45-degree field of view:
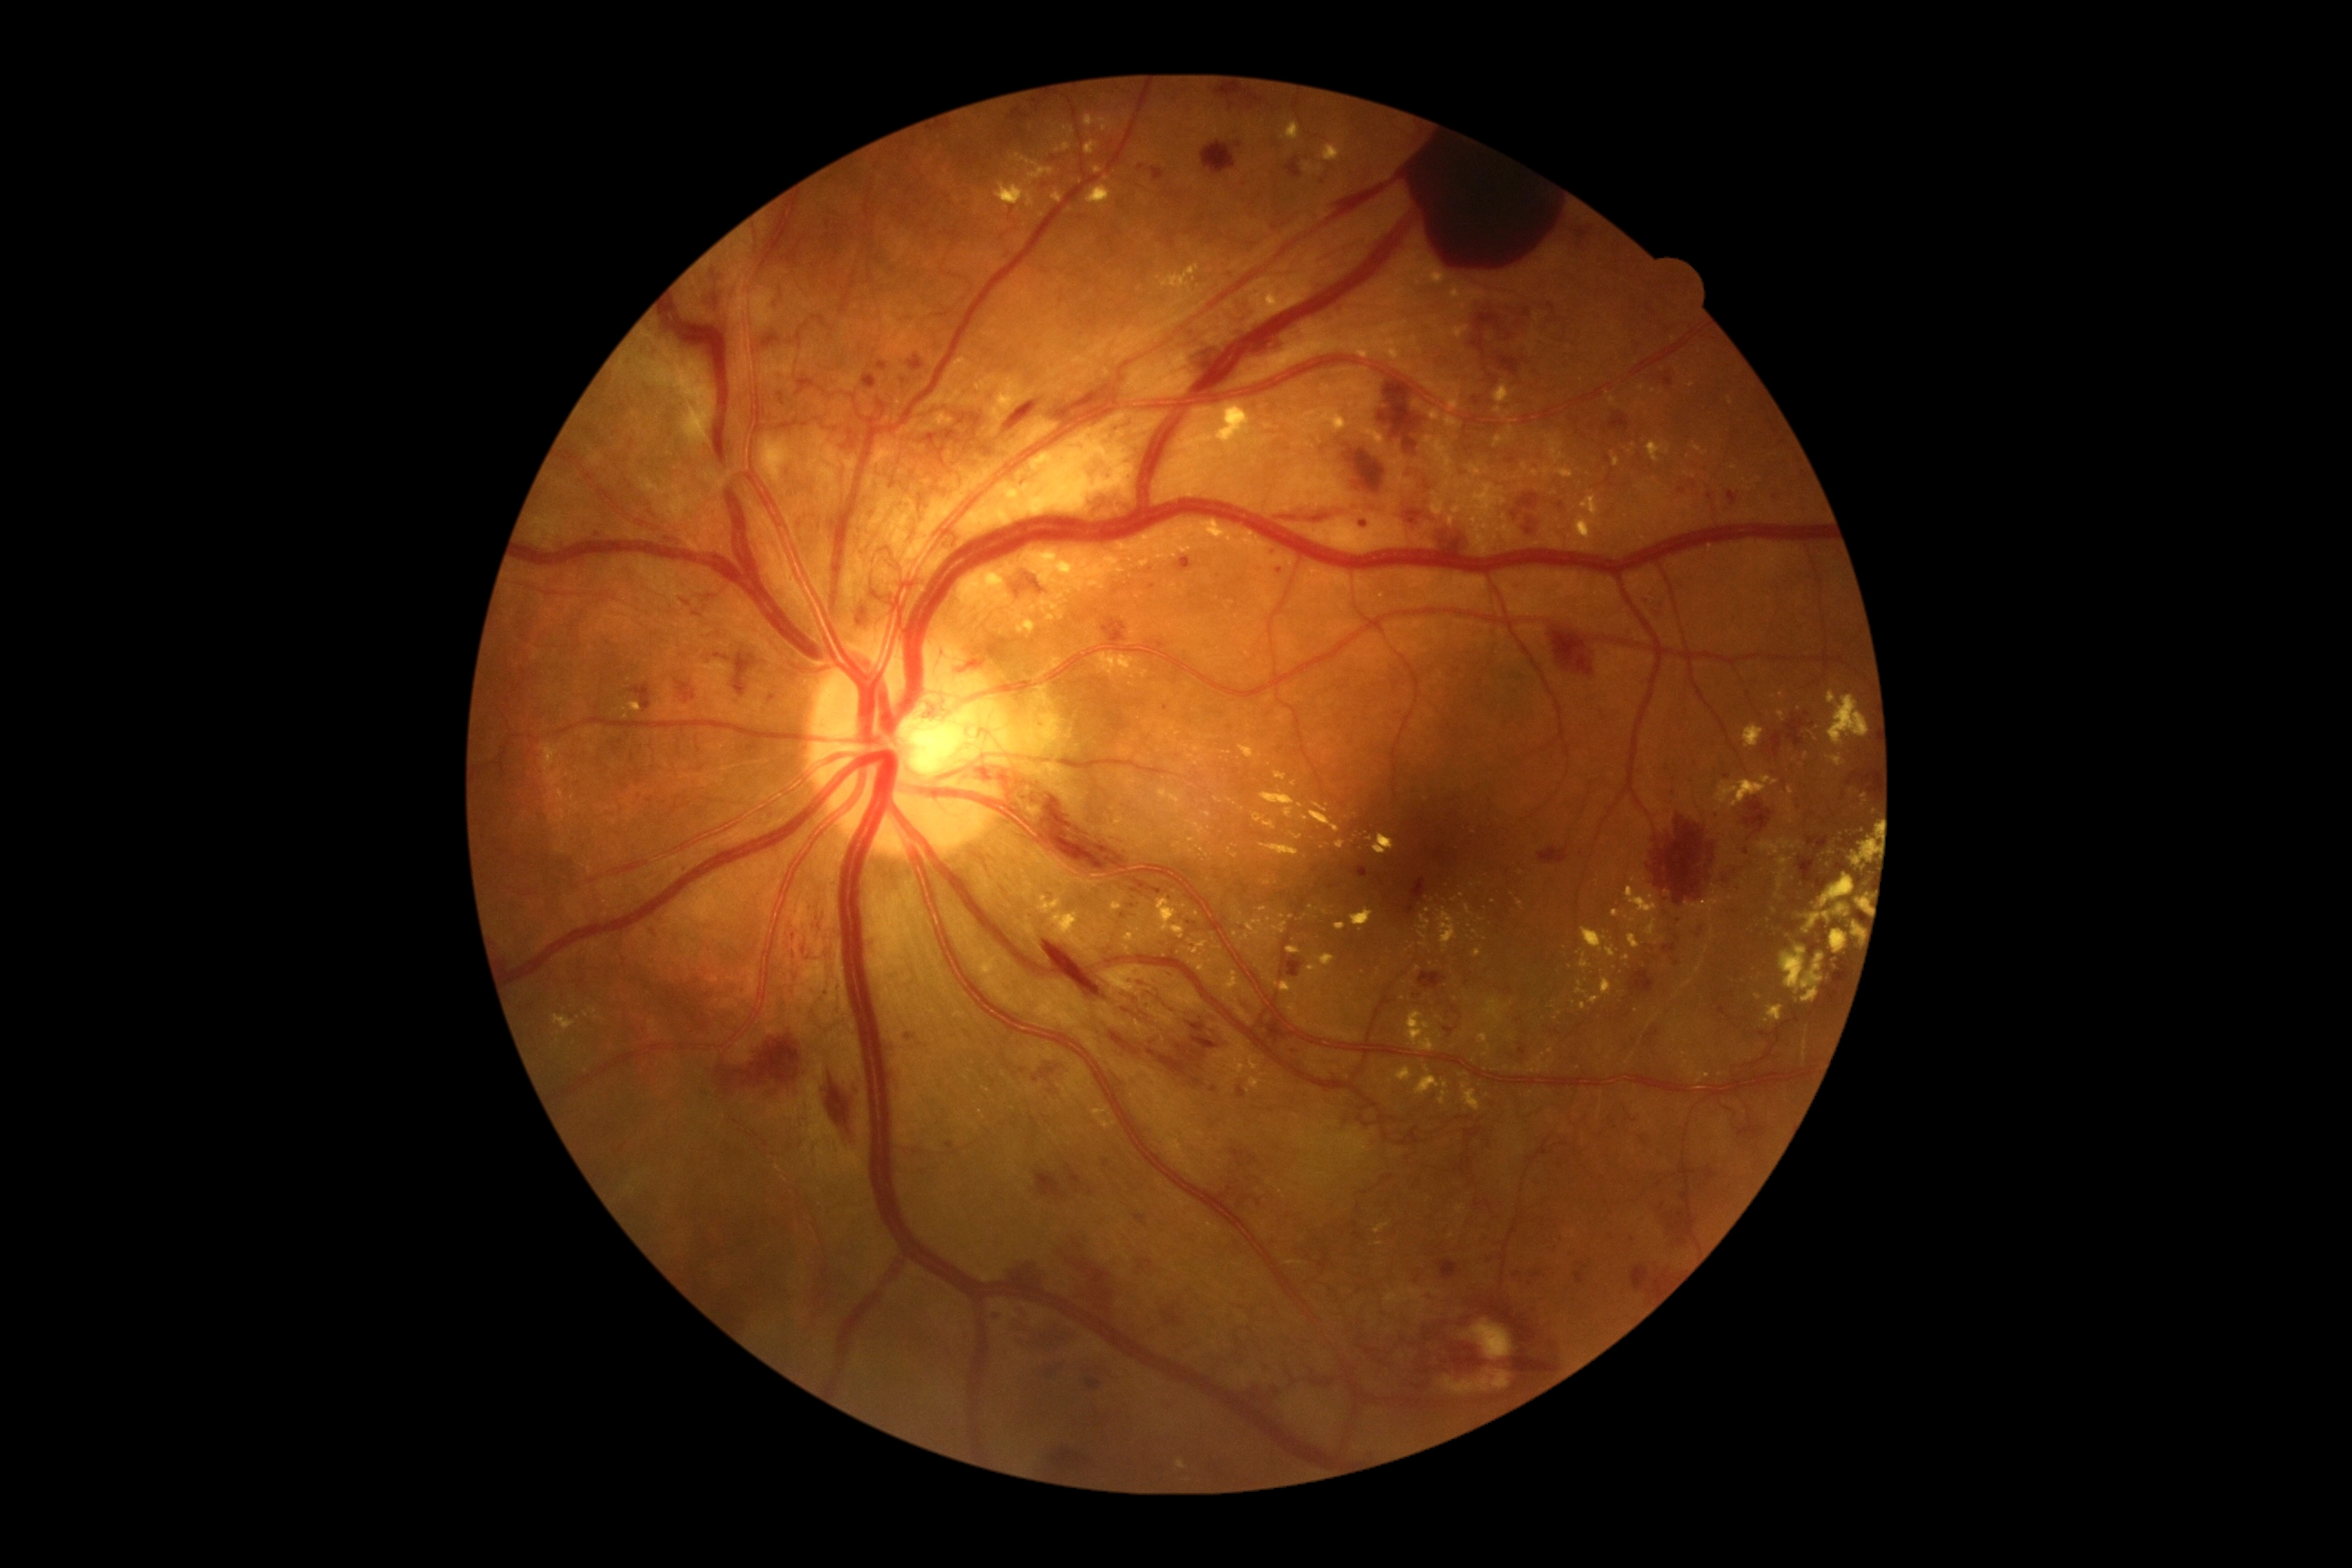

DR severity is 4/4
A subset of detected lesions:
EXs (more not shown): [x1=1182, y1=745, x2=1190, y2=750], [x1=589, y1=1006, x2=598, y2=1014], [x1=1309, y1=810, x2=1340, y2=834], [x1=1609, y1=398, x2=1616, y2=406], [x1=1228, y1=848, x2=1239, y2=858], [x1=1335, y1=839, x2=1346, y2=850], [x1=1763, y1=1006, x2=1785, y2=1024], [x1=1580, y1=954, x2=1591, y2=970], [x1=1574, y1=493, x2=1602, y2=542], [x1=1317, y1=954, x2=1335, y2=966], [x1=1529, y1=1054, x2=1554, y2=1073], [x1=1161, y1=264, x2=1204, y2=309]
Small EXs near x=1634 y=880, x=1301 y=807, x=1494 y=902, x=1507 y=1068, x=1291 y=917, x=1033 y=609